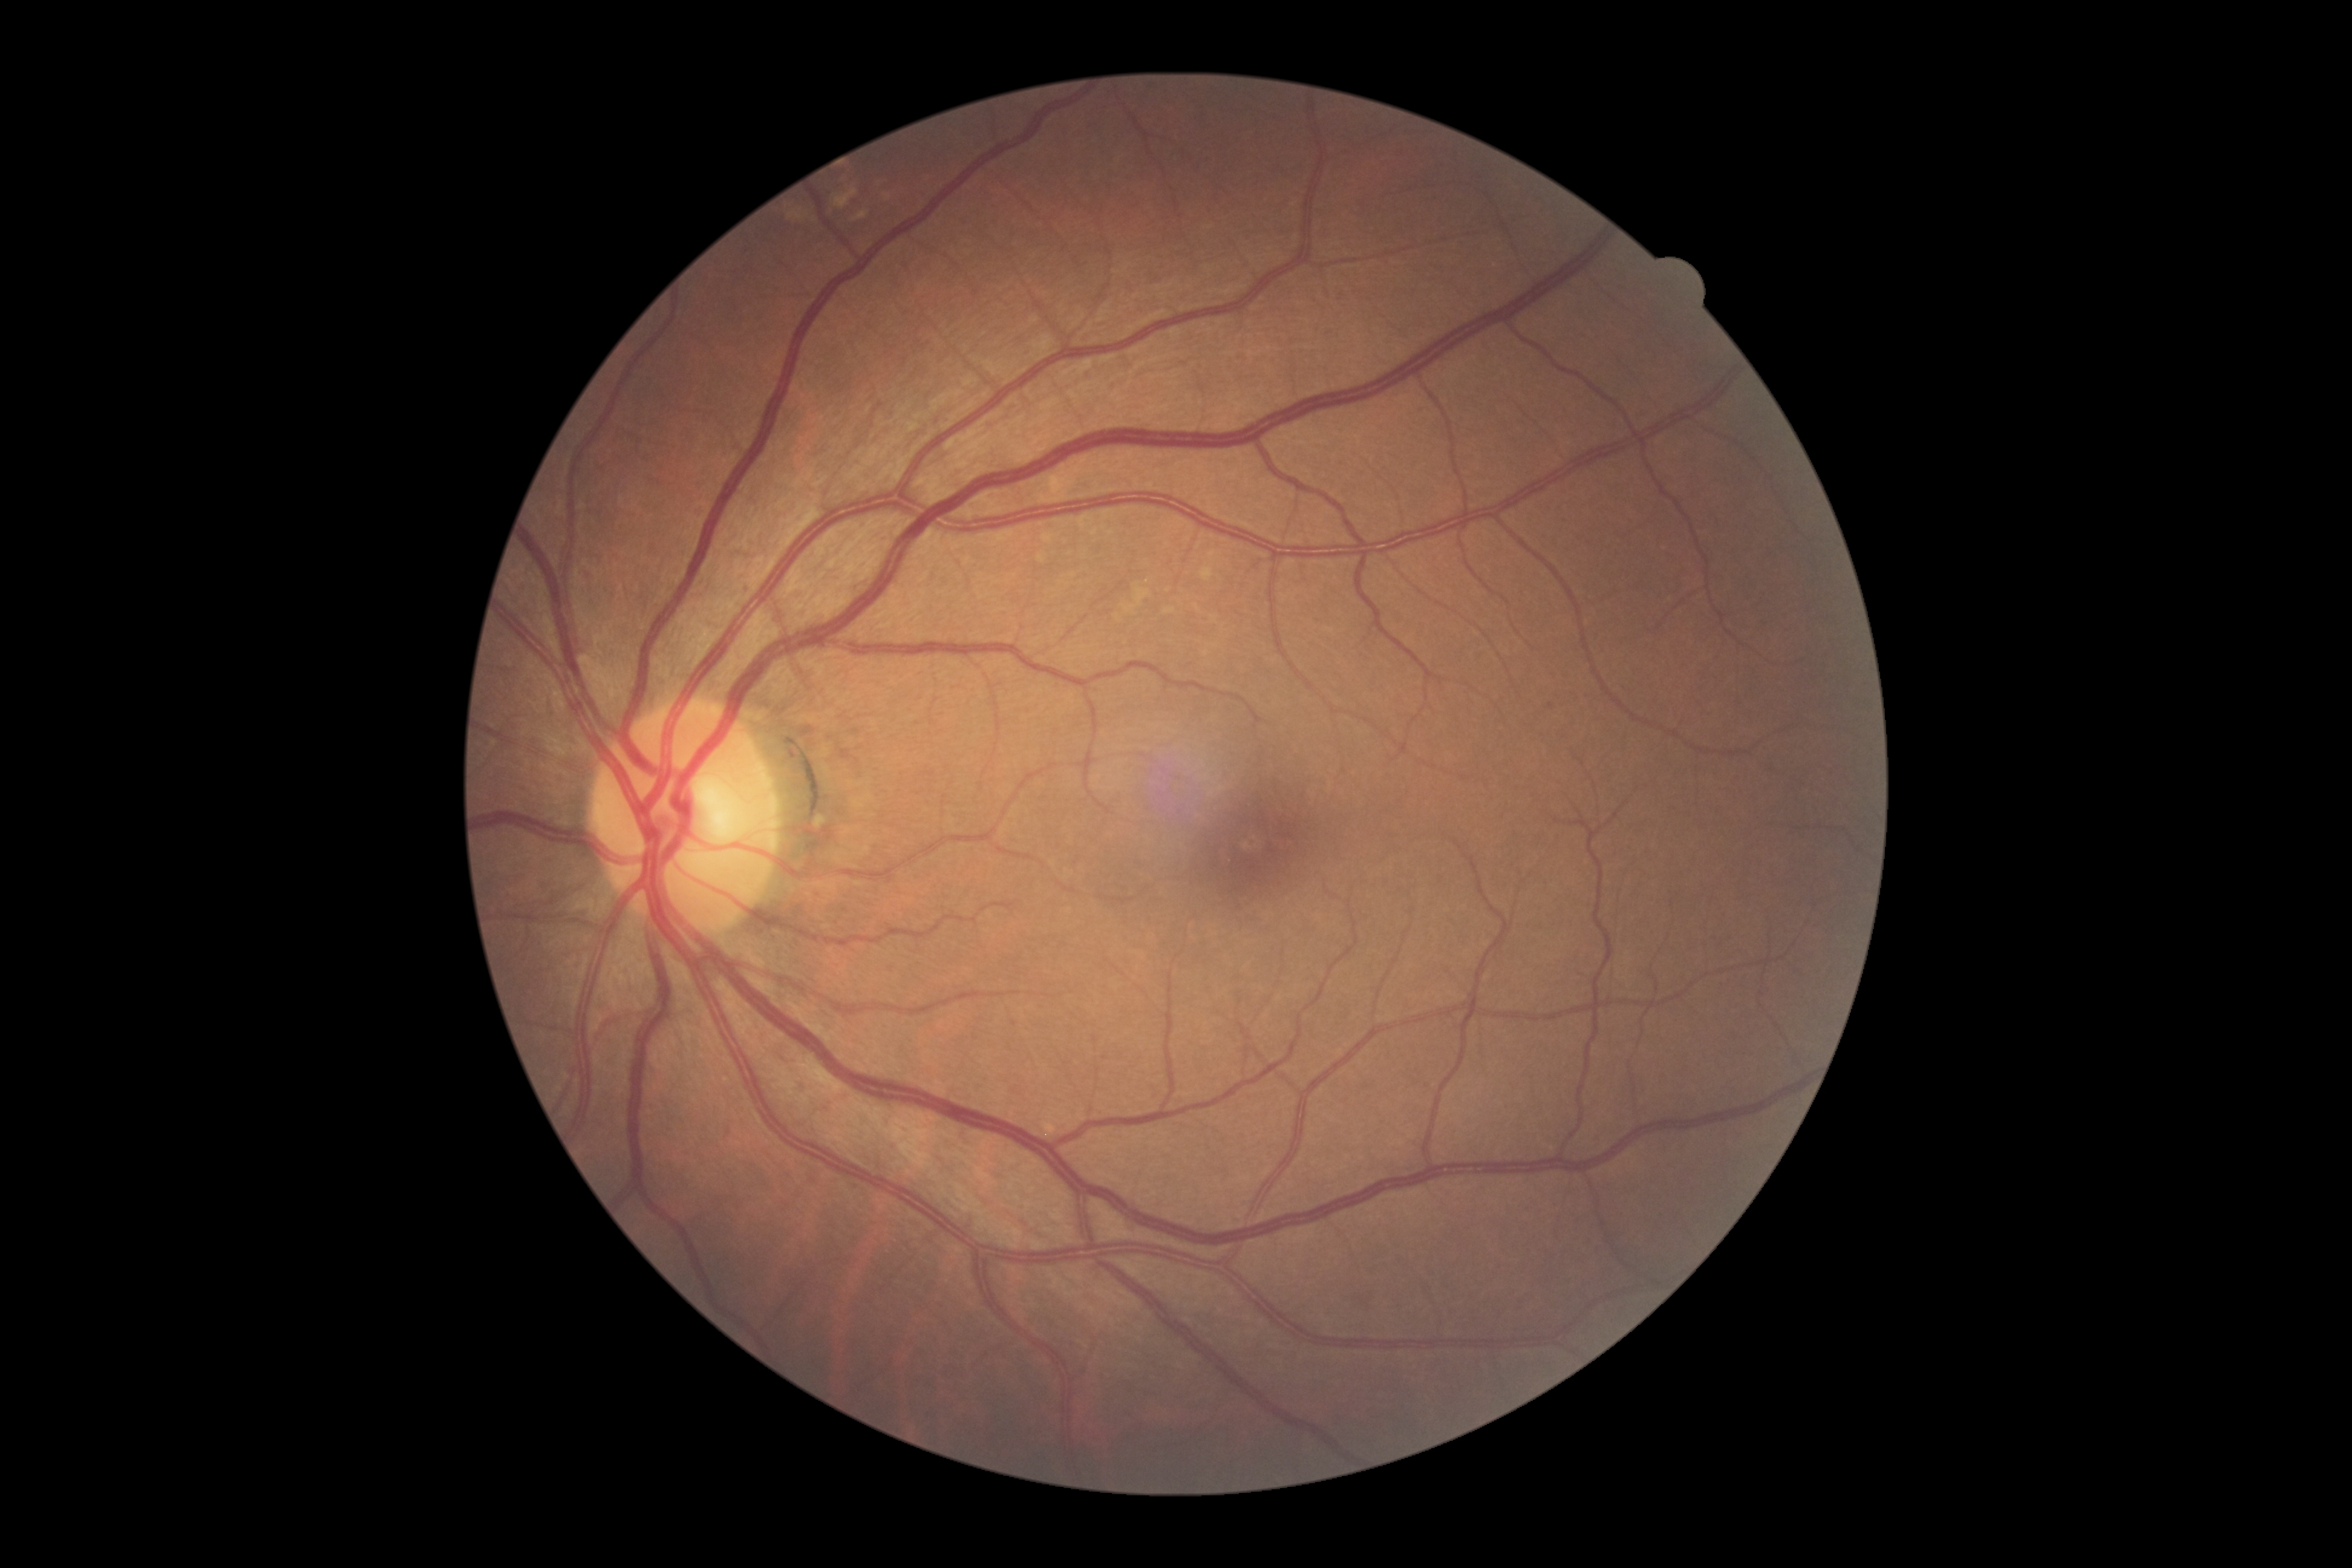
No signs of diabetic retinopathy. DR severity is no apparent retinopathy (grade 0).